Wide-field fundus image from infant ROP screening. 1240 x 1240 pixels. Camera: Phoenix ICON (100° FOV)
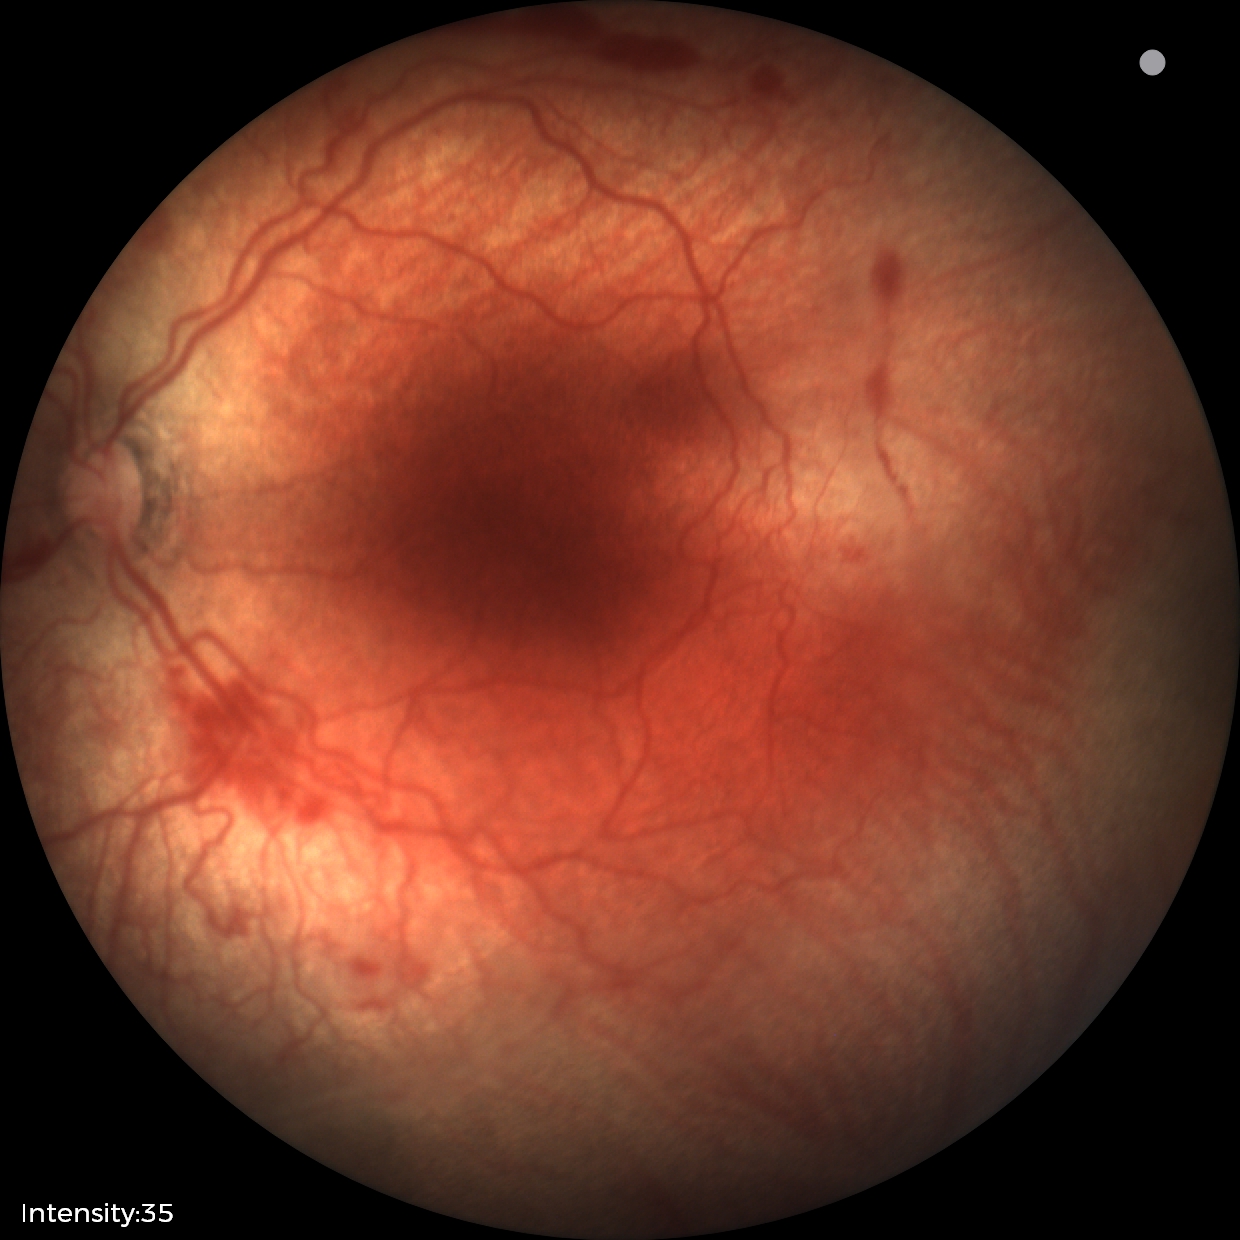
Finding = ROP stage 2
plus form = present — abnormal dilation and tortuosity of the posterior pole retinal vessels